848 x 848 pixels. NIDEK AFC-230. No pharmacologic dilation. 45 degree fundus photograph. CFP. Diabetic retinopathy graded by the modified Davis classification
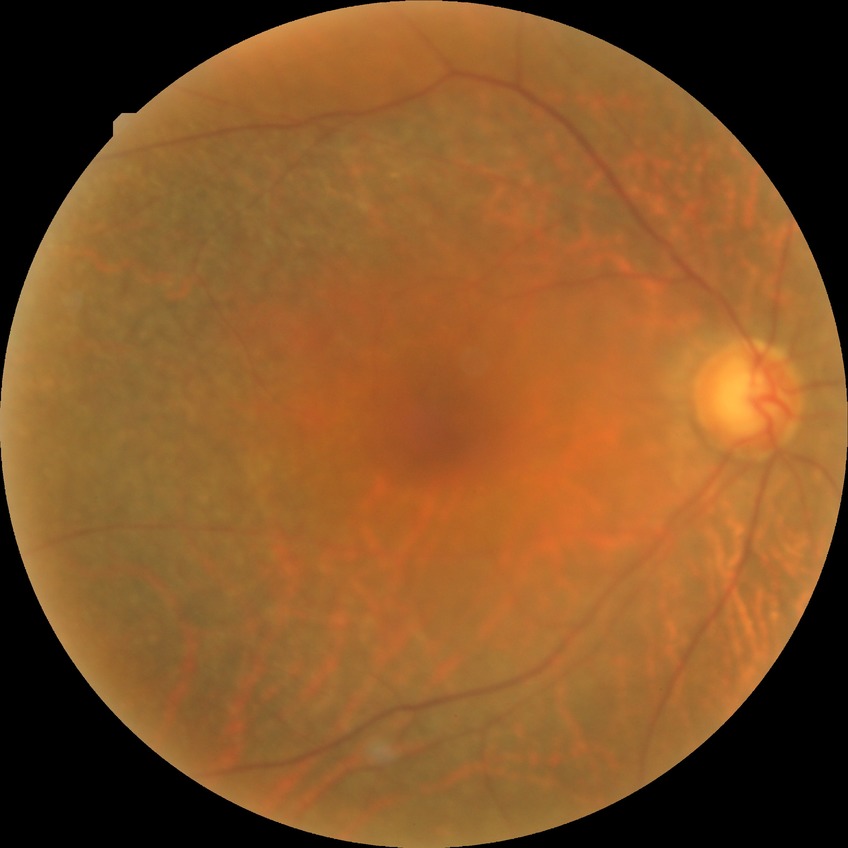 Diabetic retinopathy (DR): no diabetic retinopathy (NDR).